130° field of view (Clarity RetCam 3) · wide-field fundus photograph of an infant · 640 x 480 pixels — 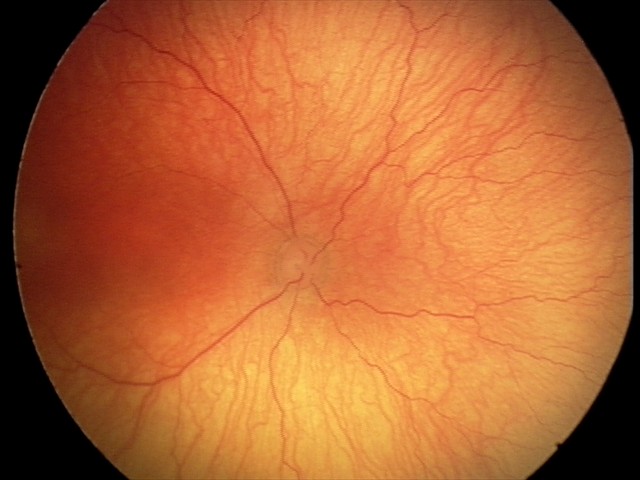 Plus disease was diagnosed.
From an examination with diagnosis of aggressive retinopathy of prematurity (A-ROP) — rapidly progressive severe ROP with prominent plus disease, often without classic stage progression.